Graded on the modified Davis scale.
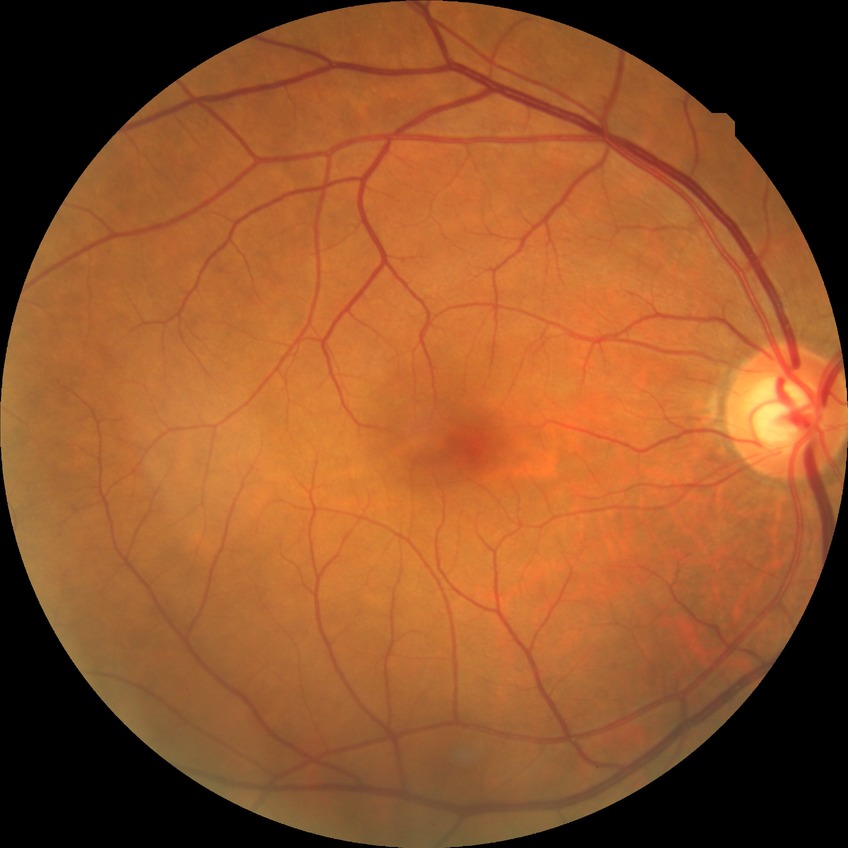

Davis DR grade=NDR.